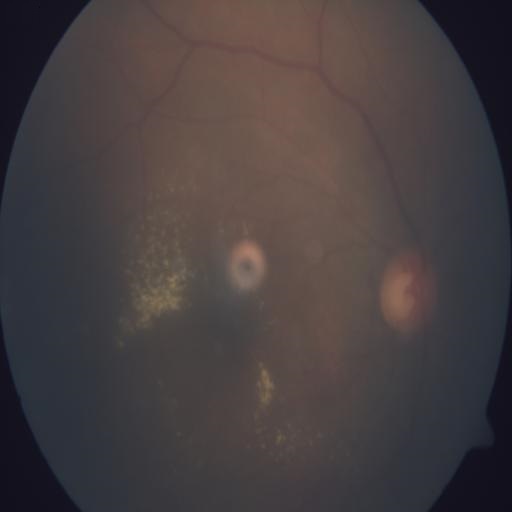

This fundus photograph shows exudation.